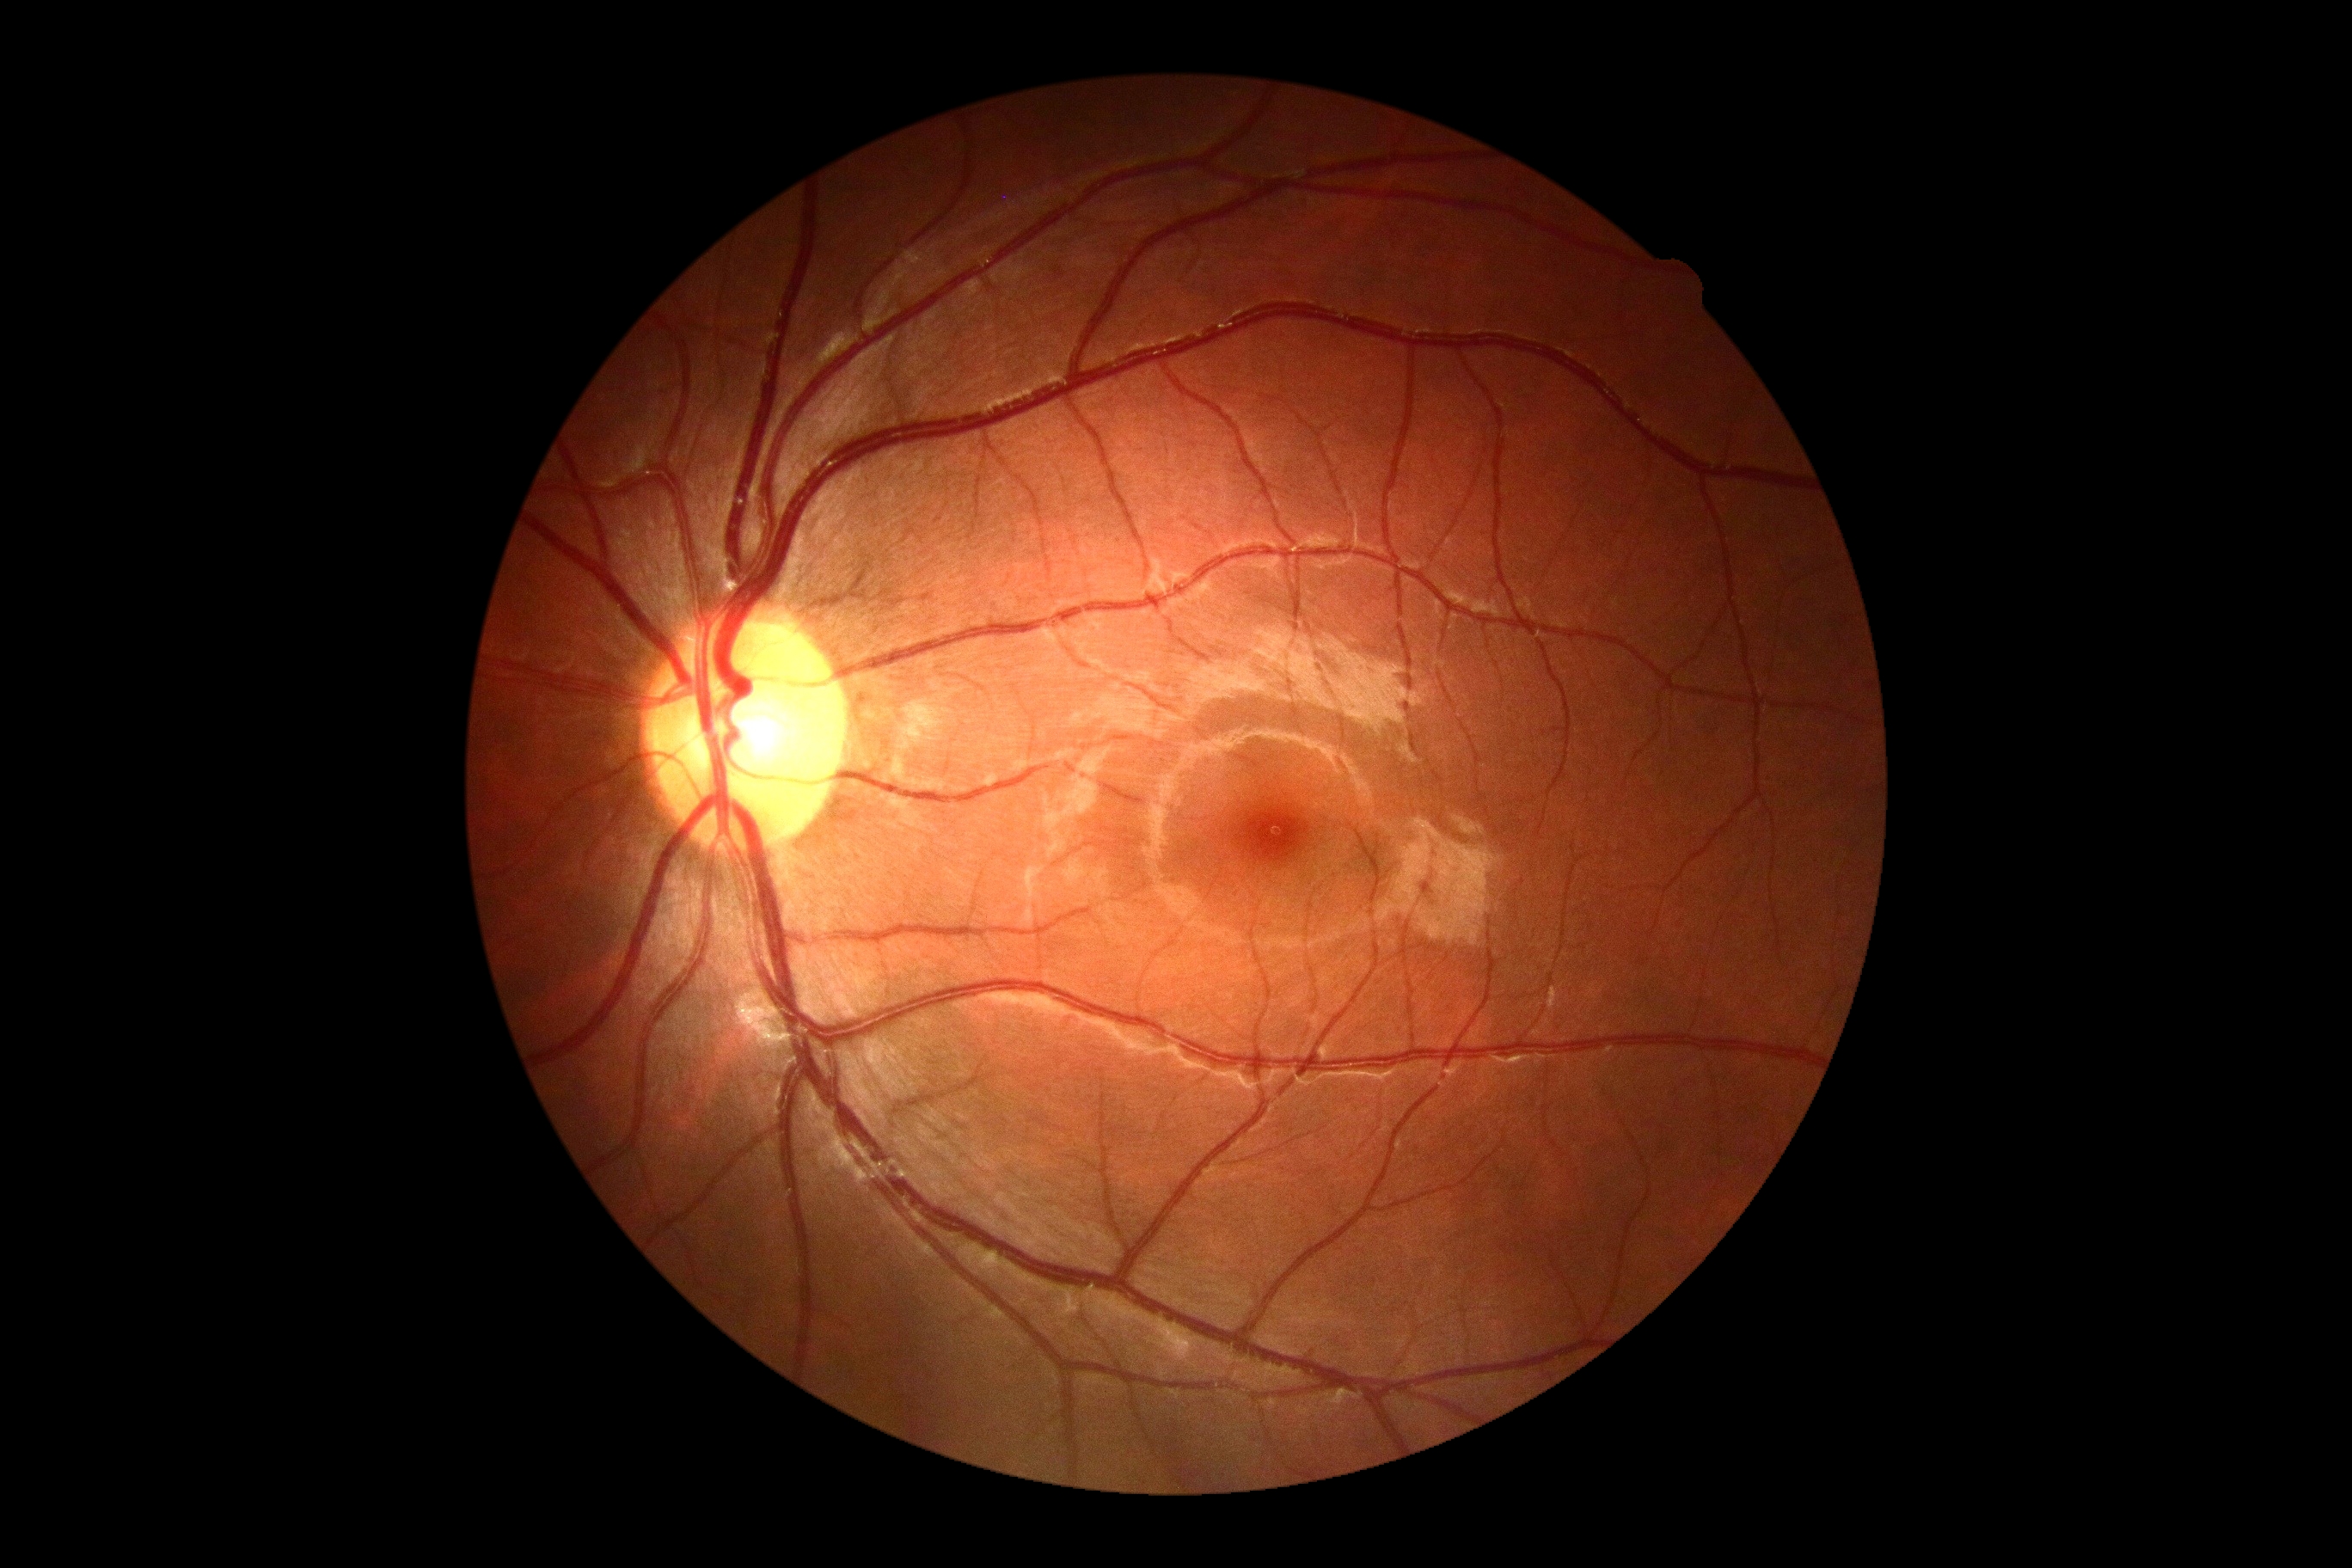
diabetic retinopathy grade = 0 — no visible signs of diabetic retinopathy
DR impression = negative for DR